45° field of view; 848 x 848 pixels; retinal fundus photograph: 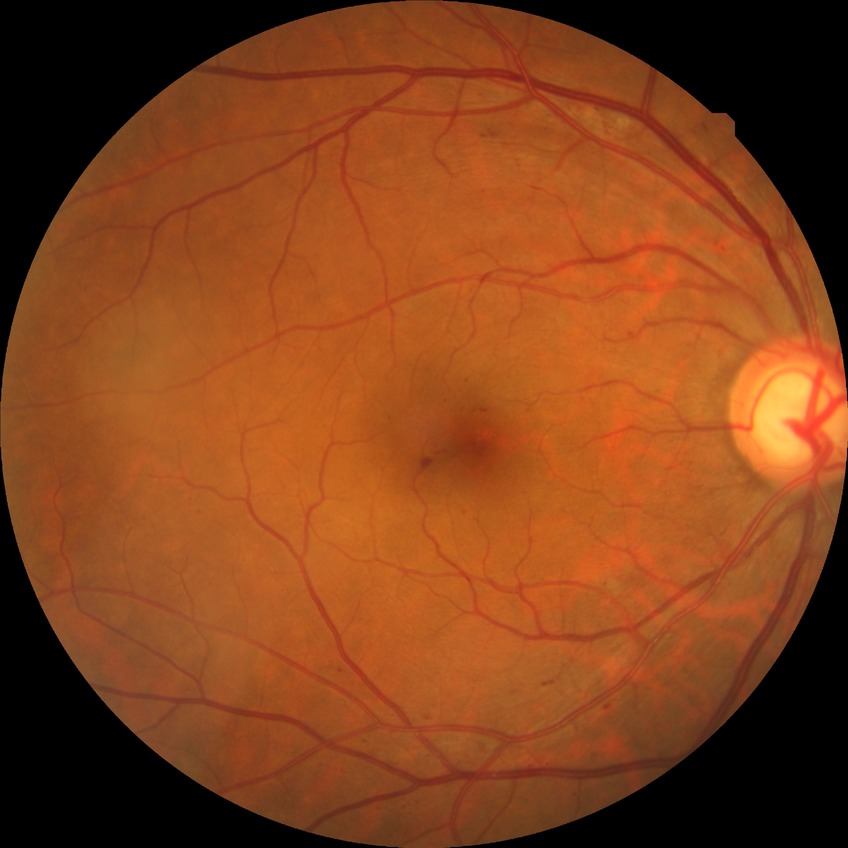

DR stage is SDR. DR class: non-proliferative diabetic retinopathy.